2212x1661 · autorefraction: -1.25 D · optic disc at the center of the field · intraocular pressure (IOP) by pneumatic tonometry: 16 mmHg · axial length: 23.22 mm · 30° field of view · female · central corneal thickness 546 µm.
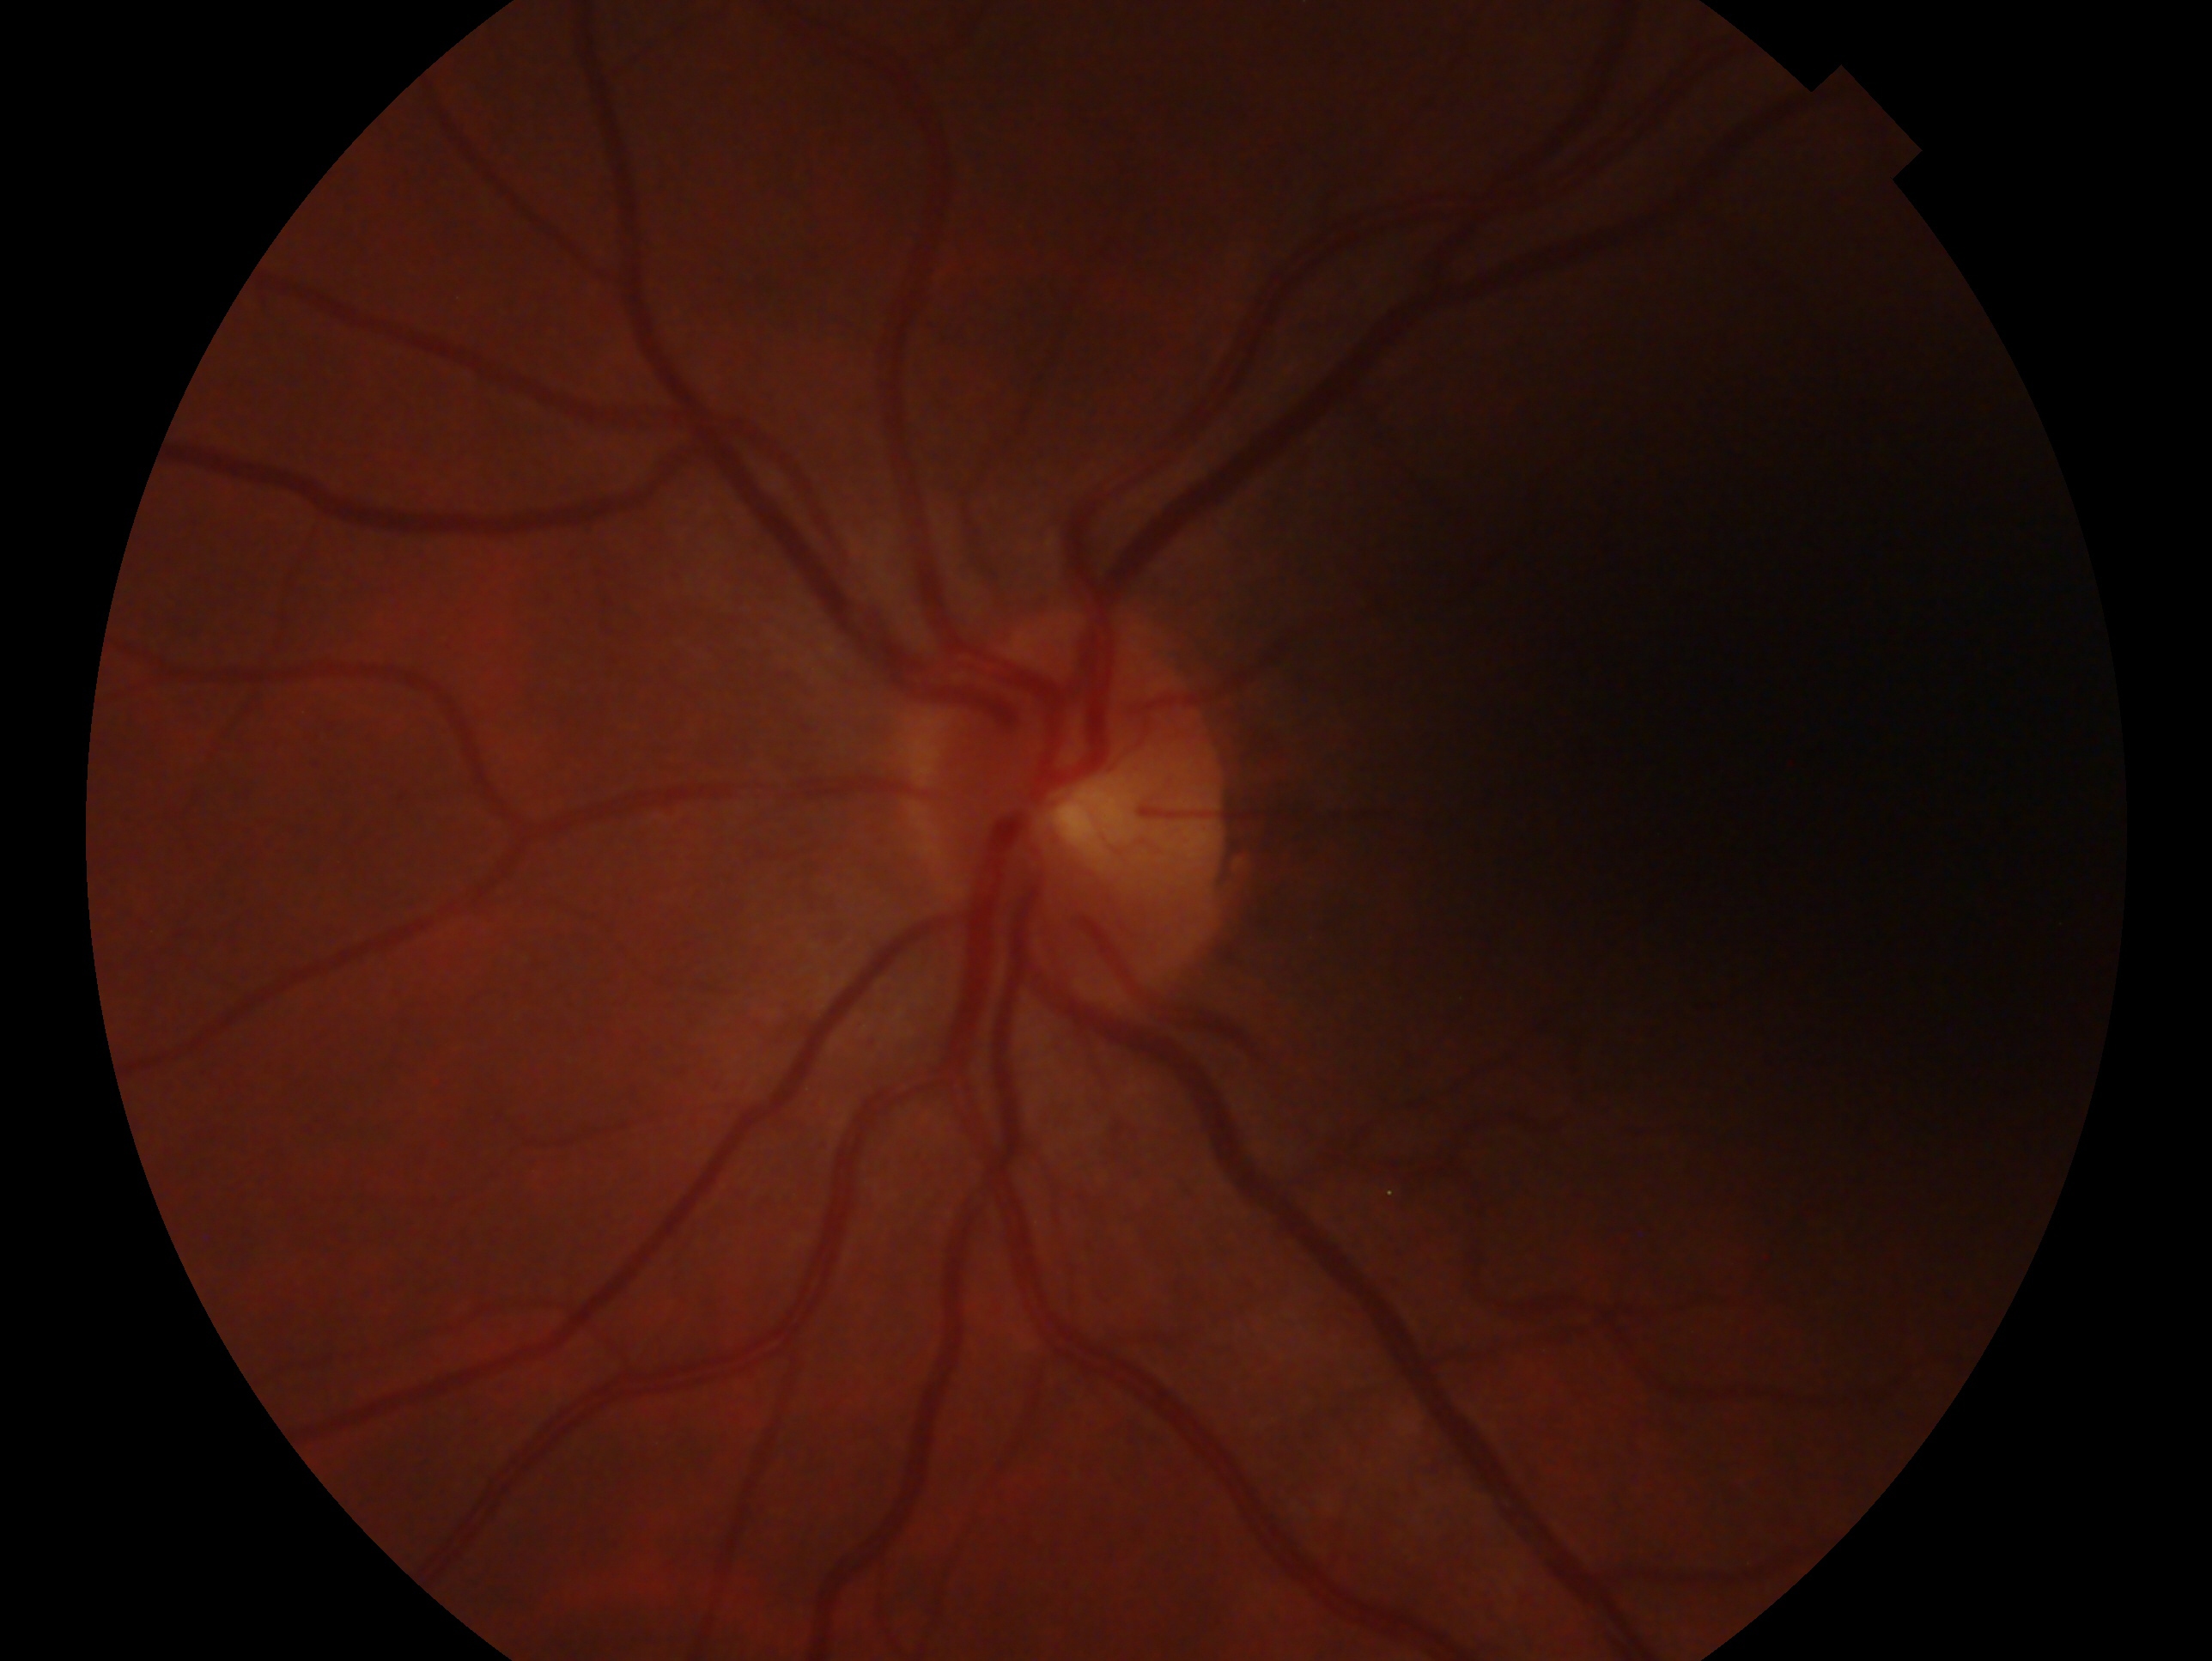
laterality: left
impression: no signs of glaucoma